45-degree field of view, no pharmacologic dilation:
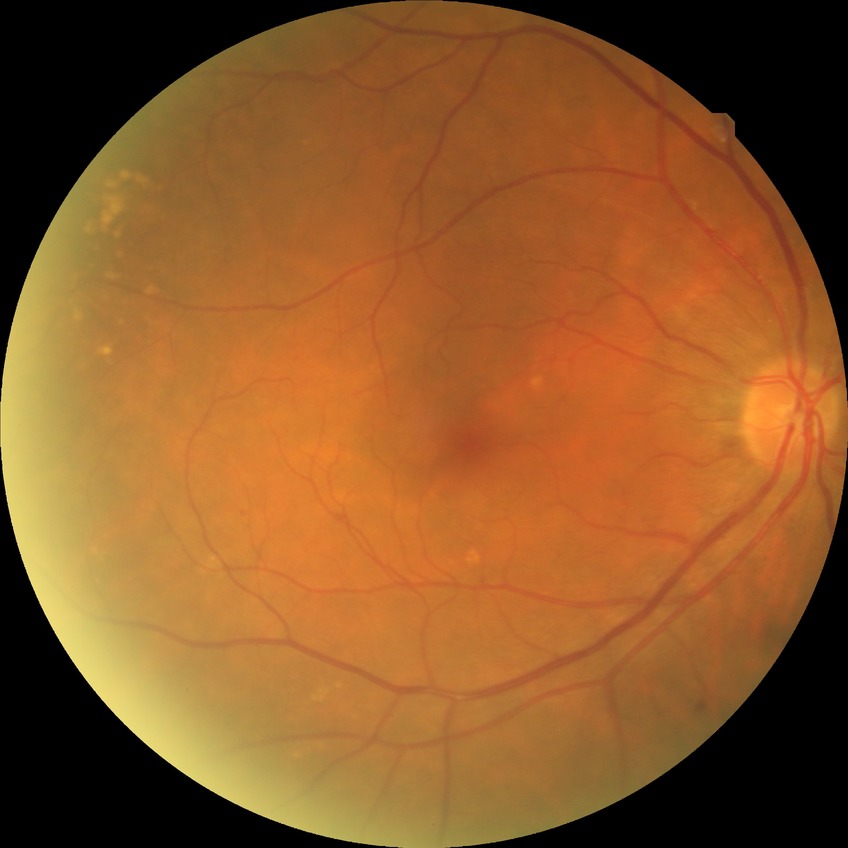
{
  "davis_grade": "simple diabetic retinopathy (SDR)"
}